Fundus photo: 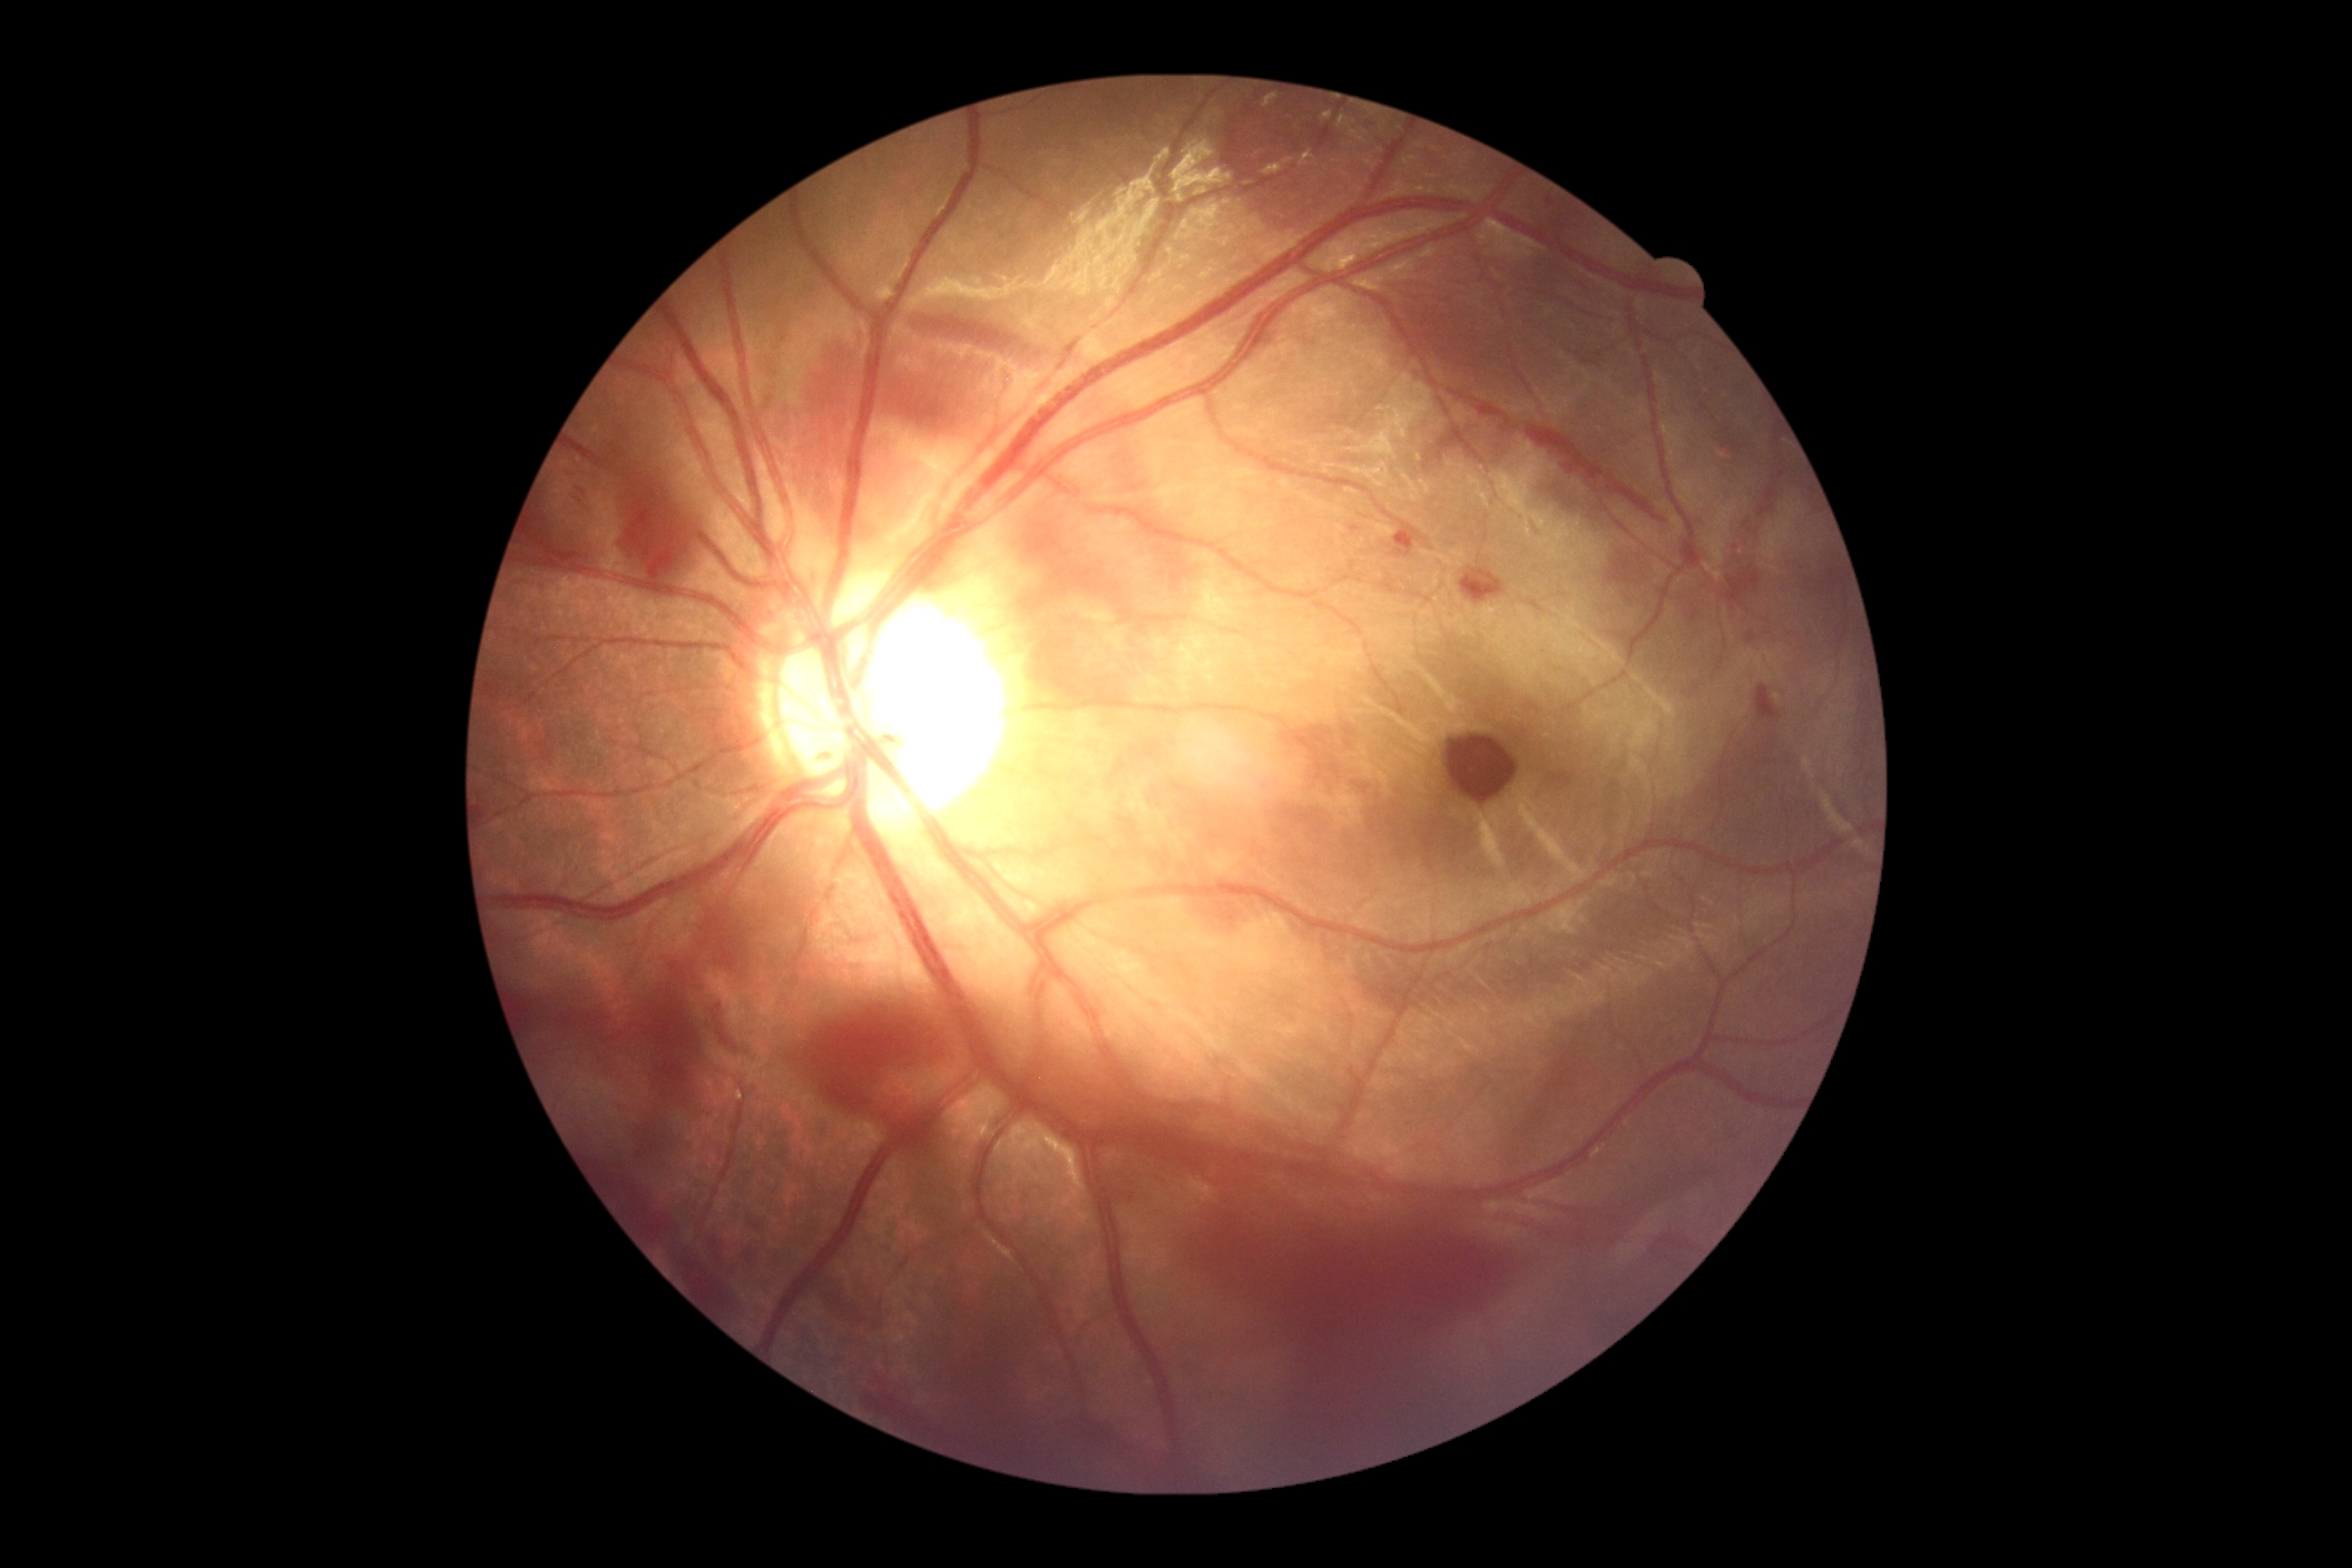
DR class = proliferative diabetic retinopathy | diabetic retinopathy (DR) = grade 4 (PDR).